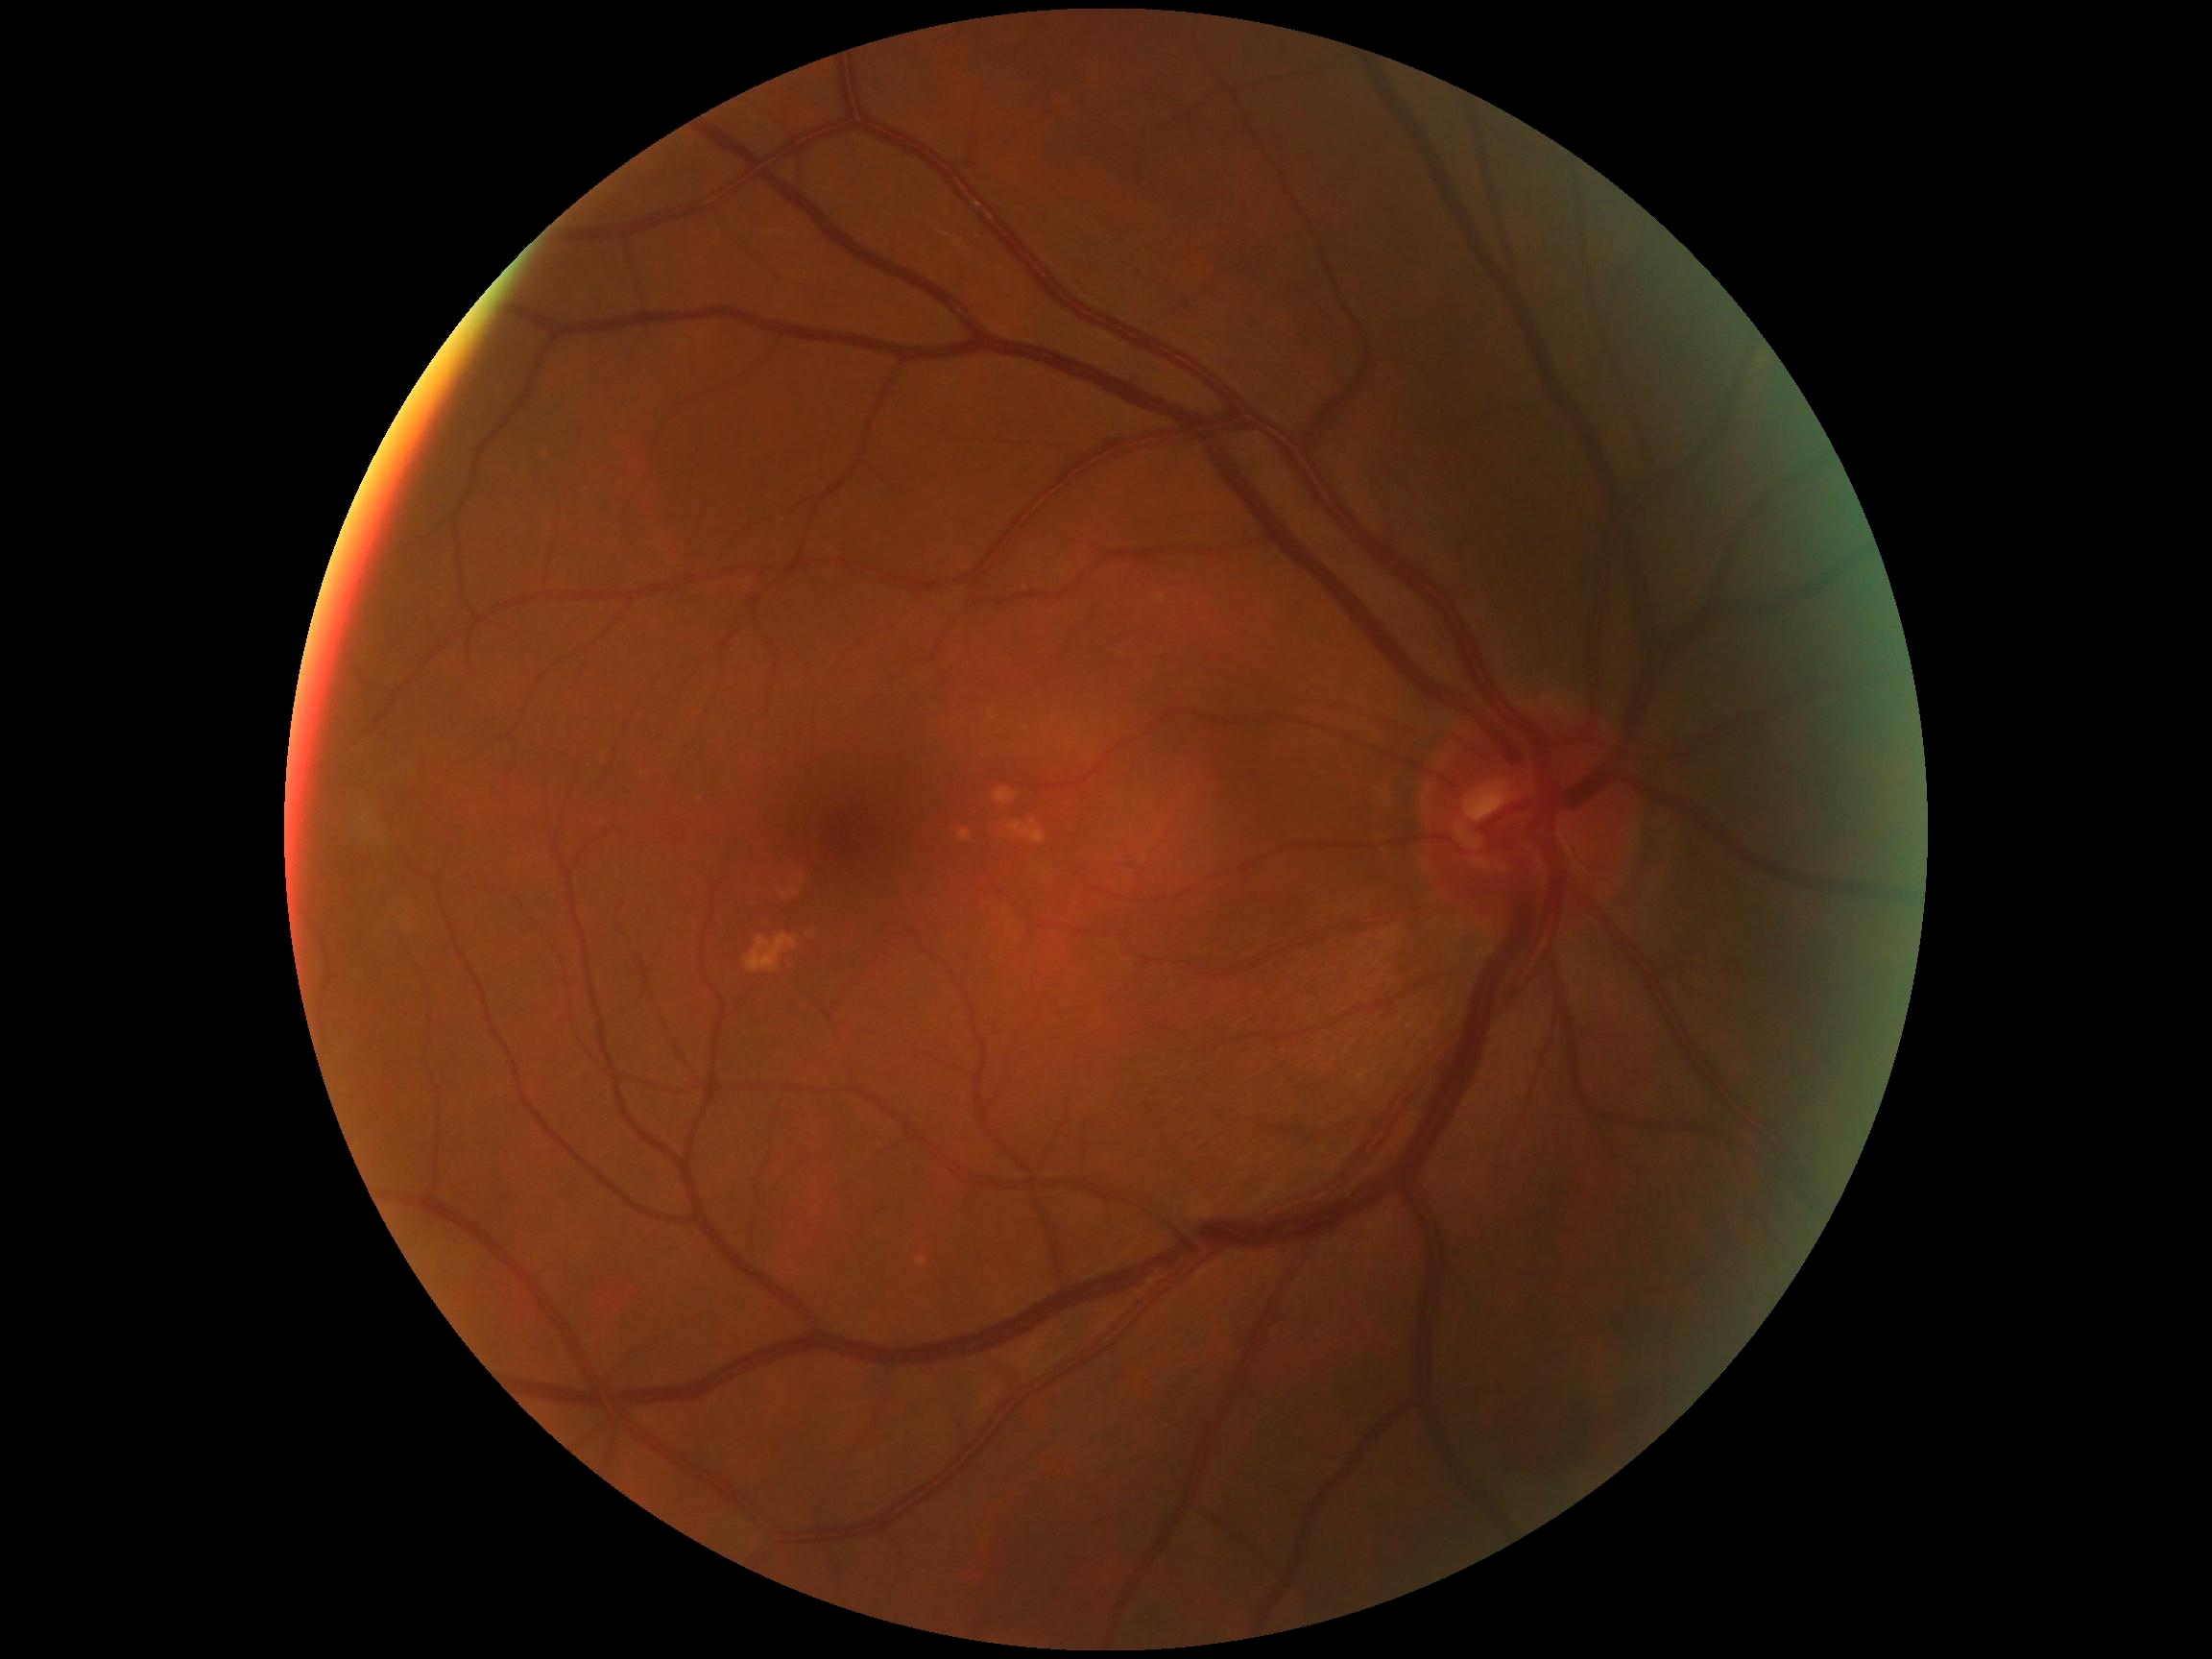

Diabetic retinopathy (DR): grade 0 (no apparent retinopathy).